Wide-field fundus image from infant ROP screening · 640x480px.
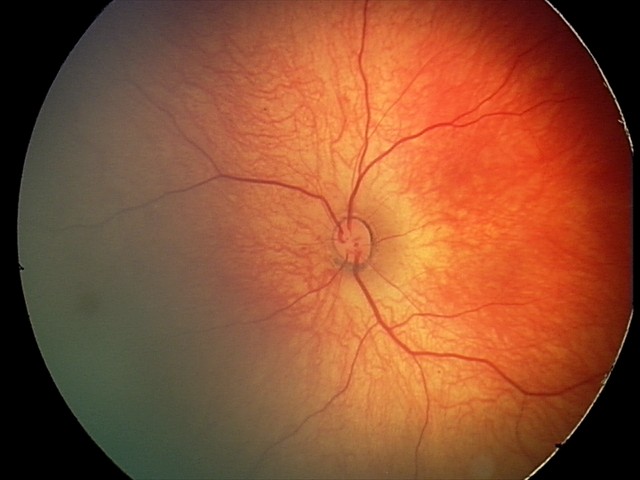 Q: What is the diagnosis from this examination?
A: retinal hemorrhages